Image size 1932x1910. 45° field of view:
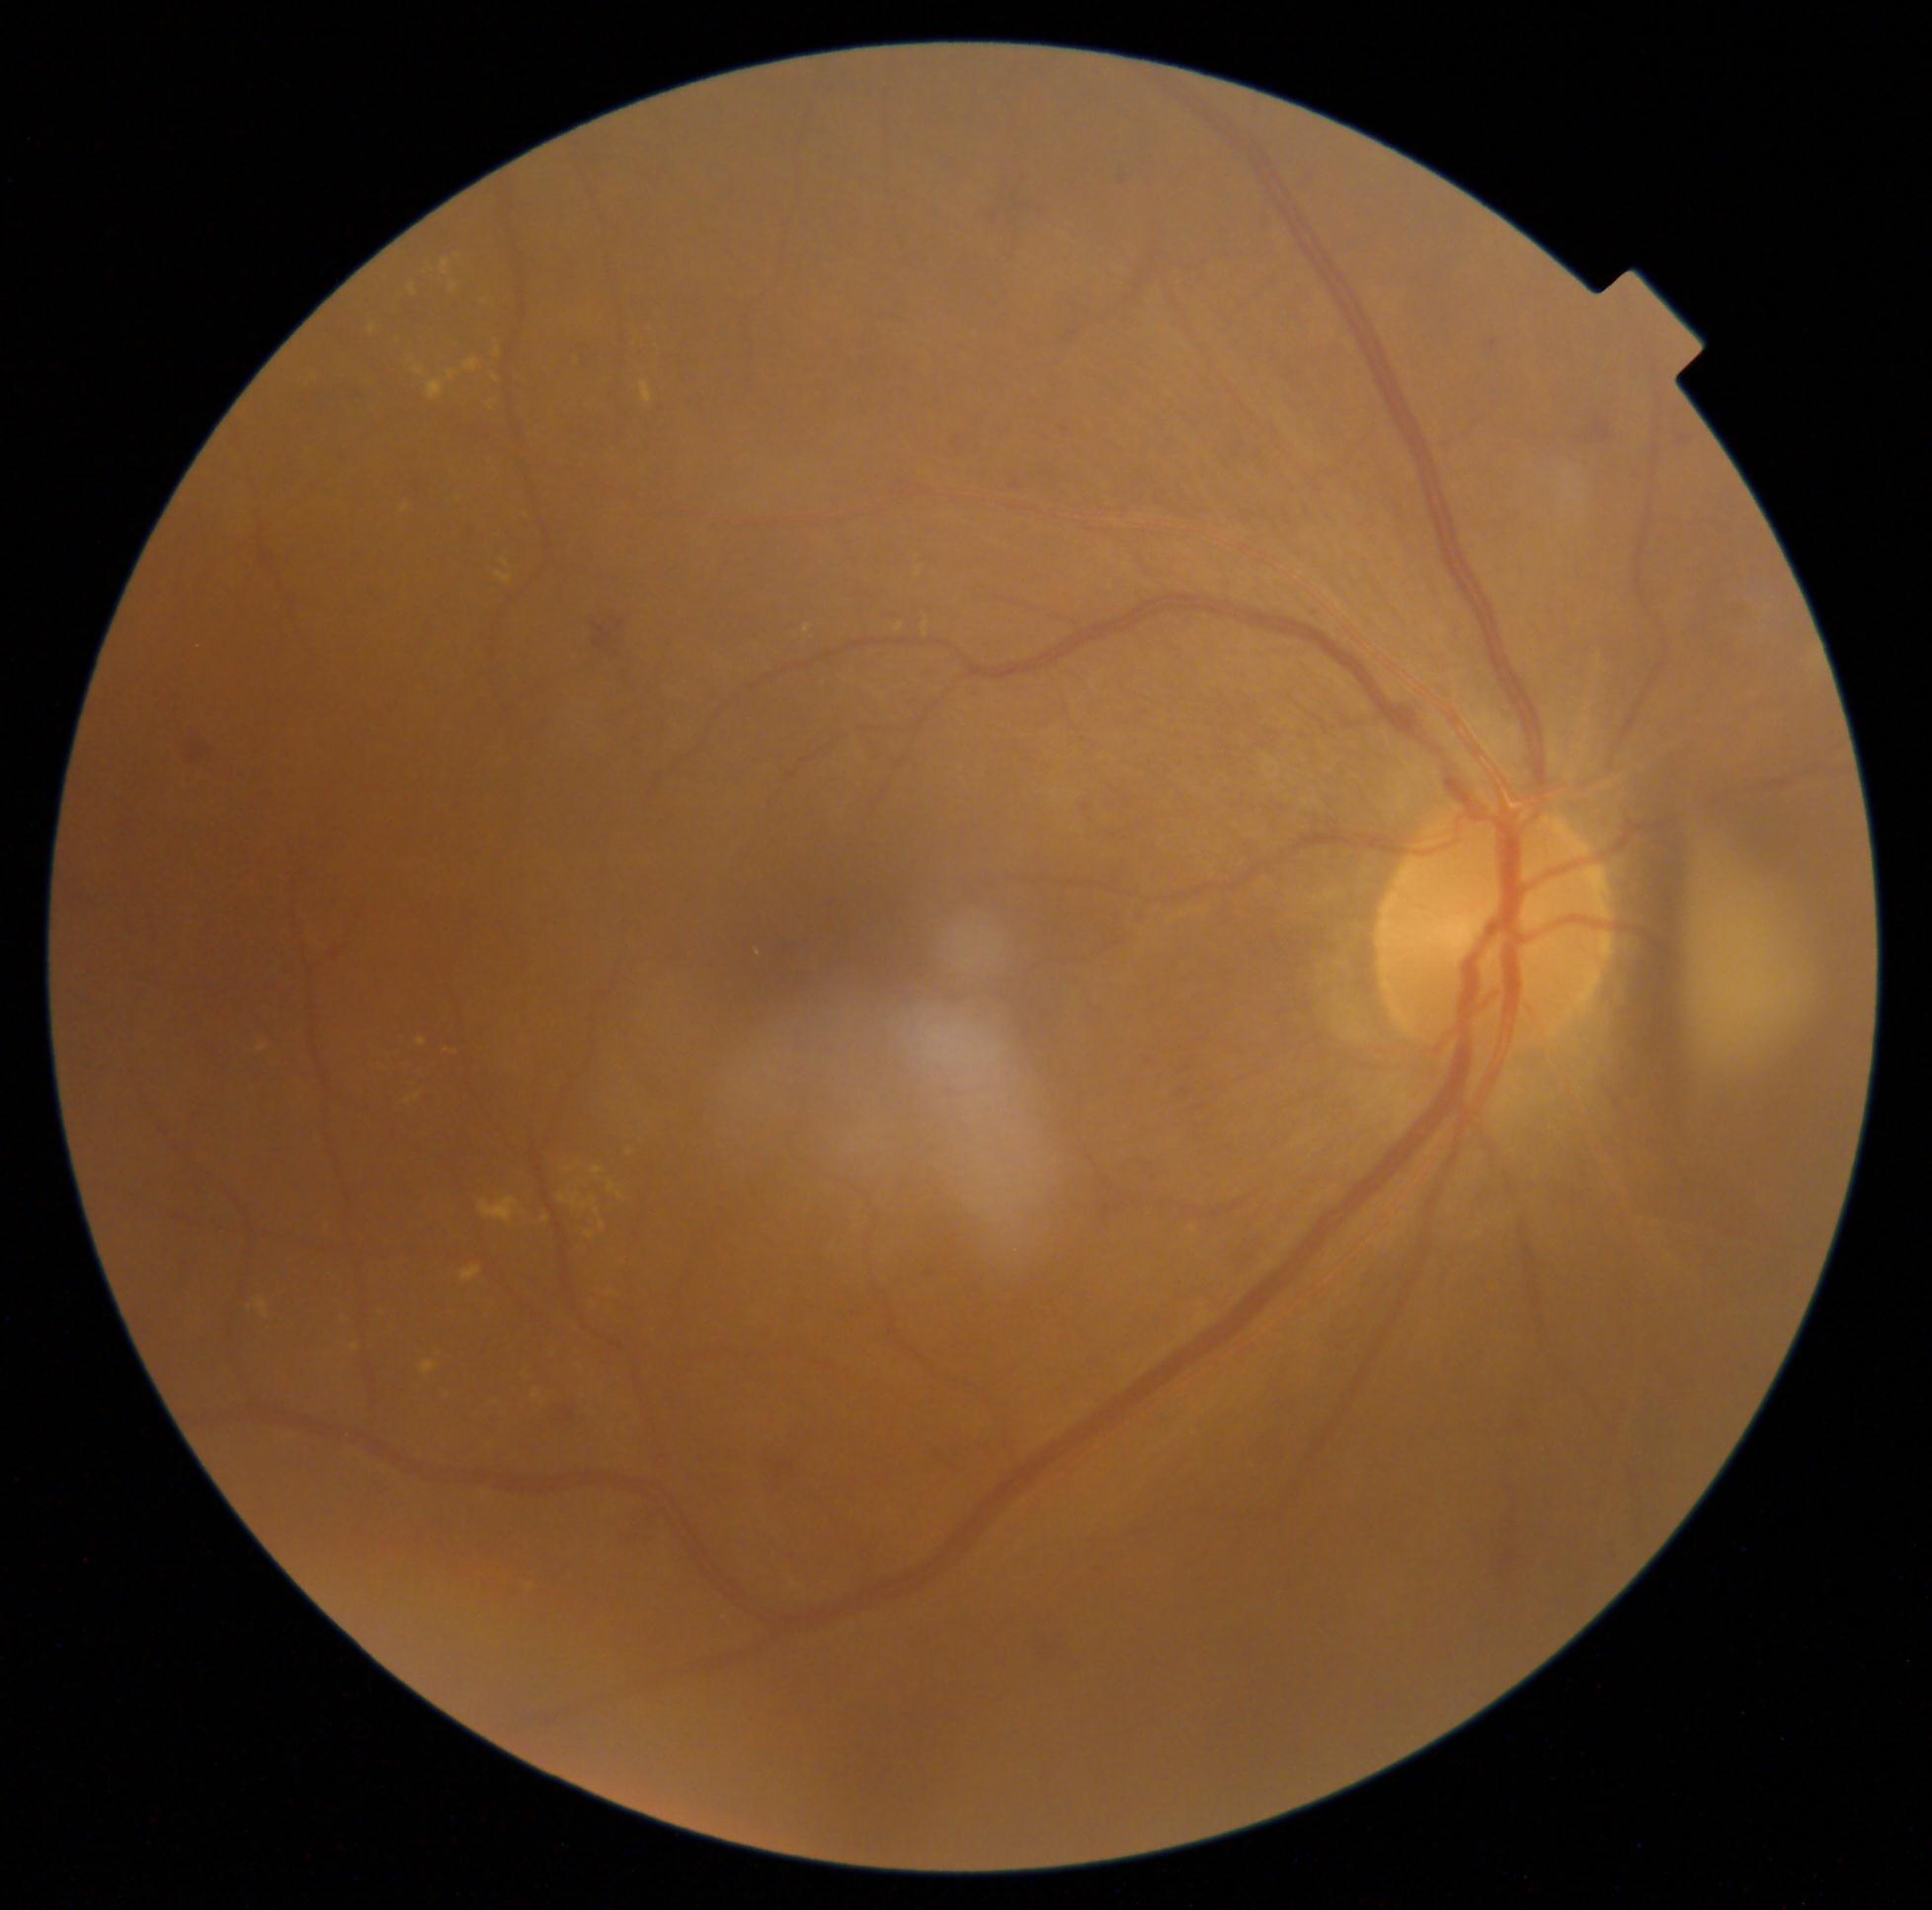 DR: 2
A subset of detected lesions:
- EXs (partial): x1=495, y1=573, x2=513, y2=586, x1=406, y1=1094, x2=420, y2=1105, x1=402, y1=505, x2=409, y2=514, x1=590, y1=1198, x2=597, y2=1206, x1=532, y1=1390, x2=541, y2=1398, x1=461, y1=1266, x2=482, y2=1283, x1=422, y1=1361, x2=436, y2=1374, x1=495, y1=349, x2=500, y2=358, x1=305, y1=368, x2=314, y2=383, x1=369, y1=326, x2=377, y2=335, x1=475, y1=297, x2=484, y2=310, x1=377, y1=1310, x2=387, y2=1316
- Small EXs approximately at {"x": 491, "y": 406}, {"x": 598, "y": 1212}, {"x": 496, "y": 380}, {"x": 564, "y": 1200}